853 by 853 pixels · fundus photograph cropped around the optic nerve head: 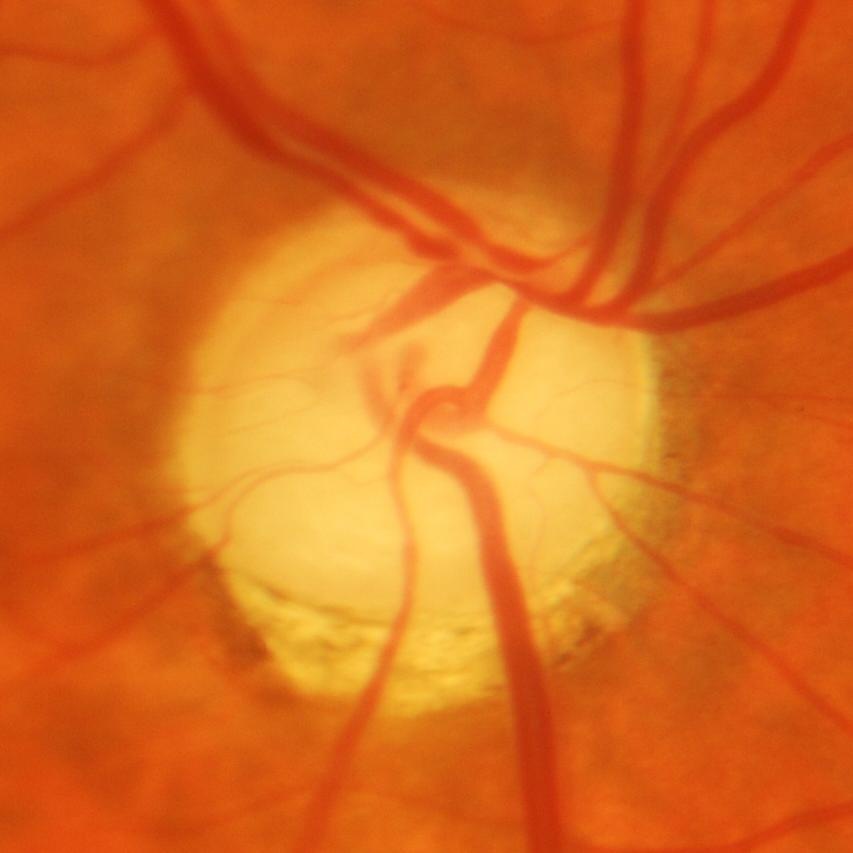

The image shows evidence of glaucoma.